FOV: 45 degrees.
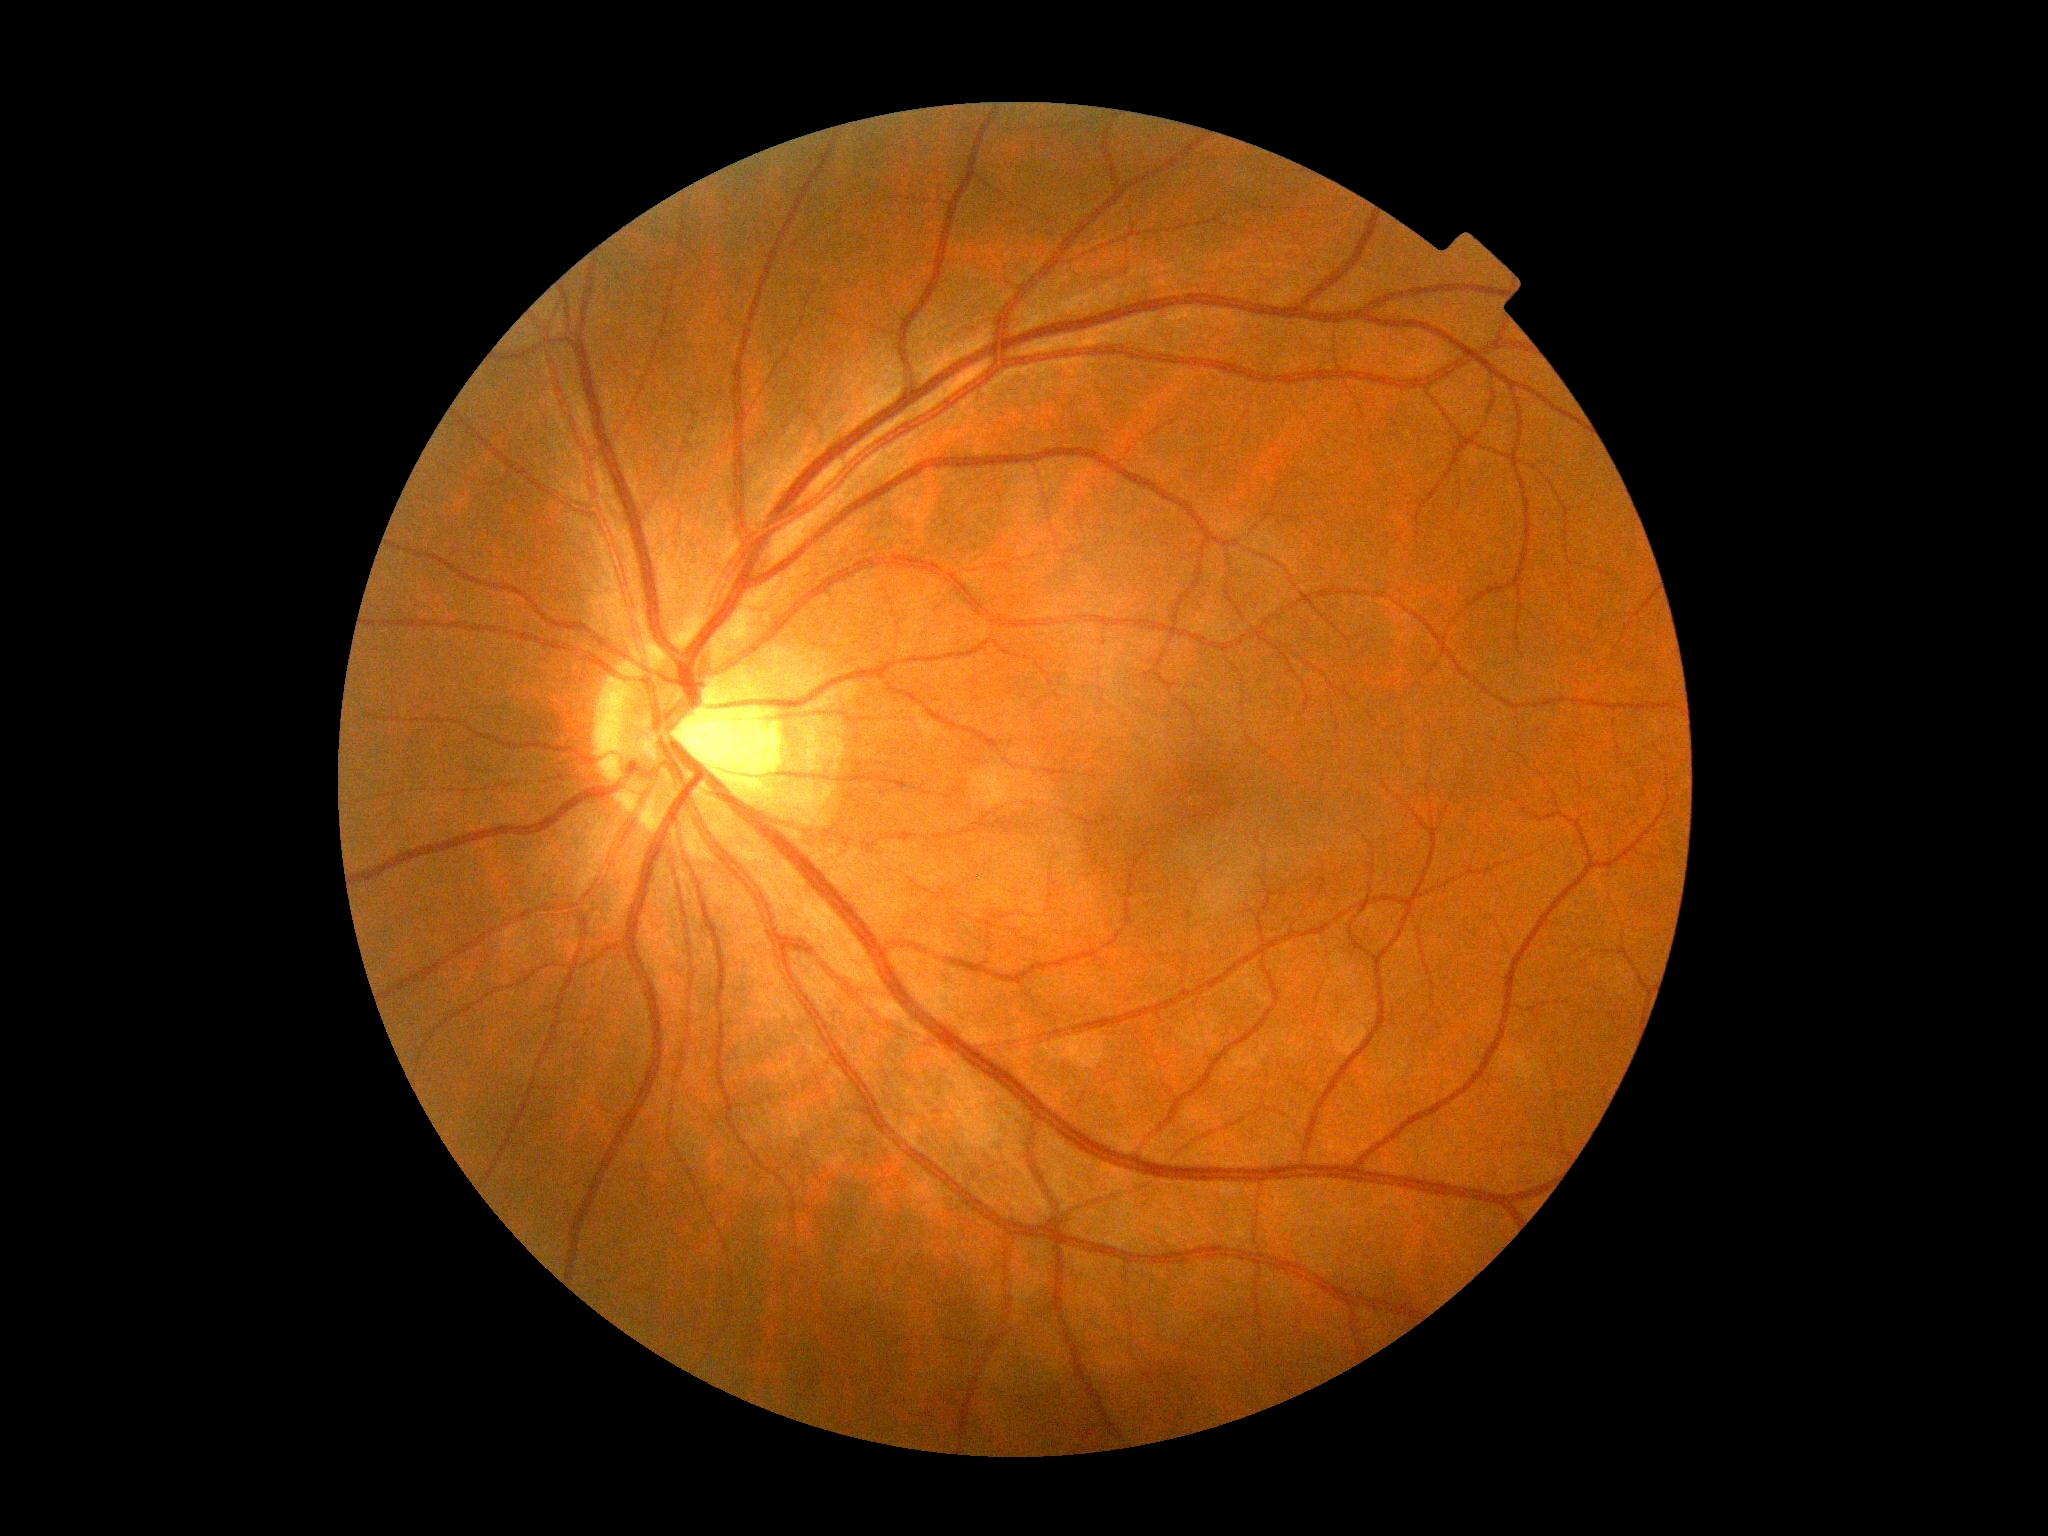 Diabetic retinopathy: 0. No diabetic retinal disease findings.